Wide-field fundus image from infant ROP screening.
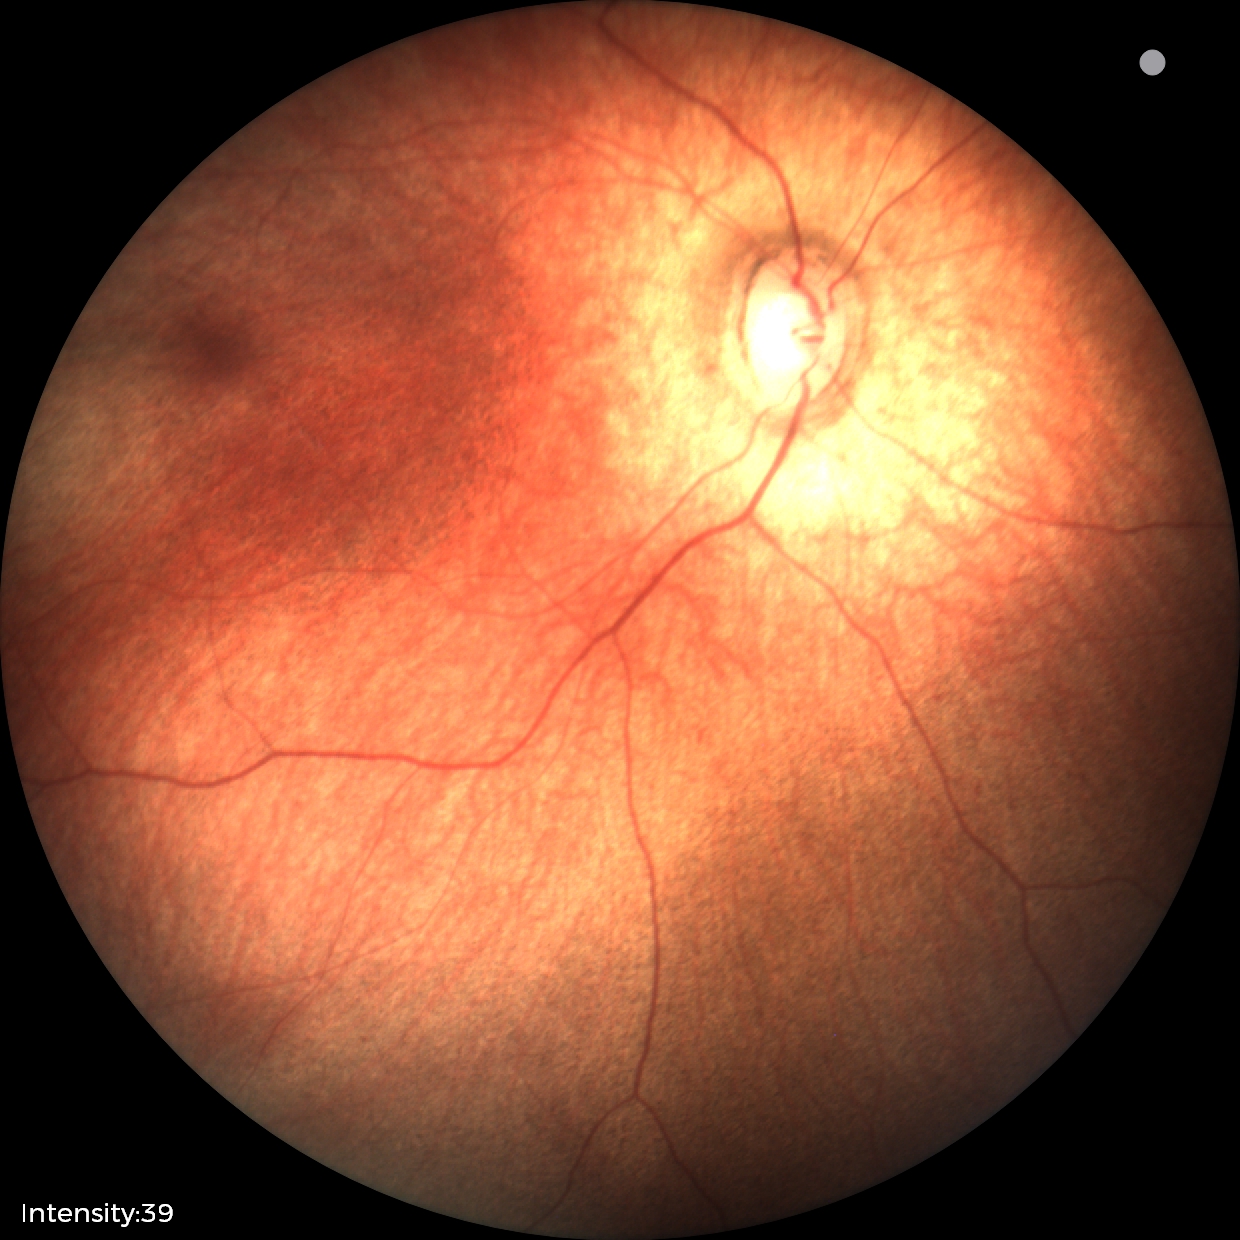
Impression: normal fundus examination.